Dilated-pupil acquisition. CFP. 50° FOV. Posterior pole view:
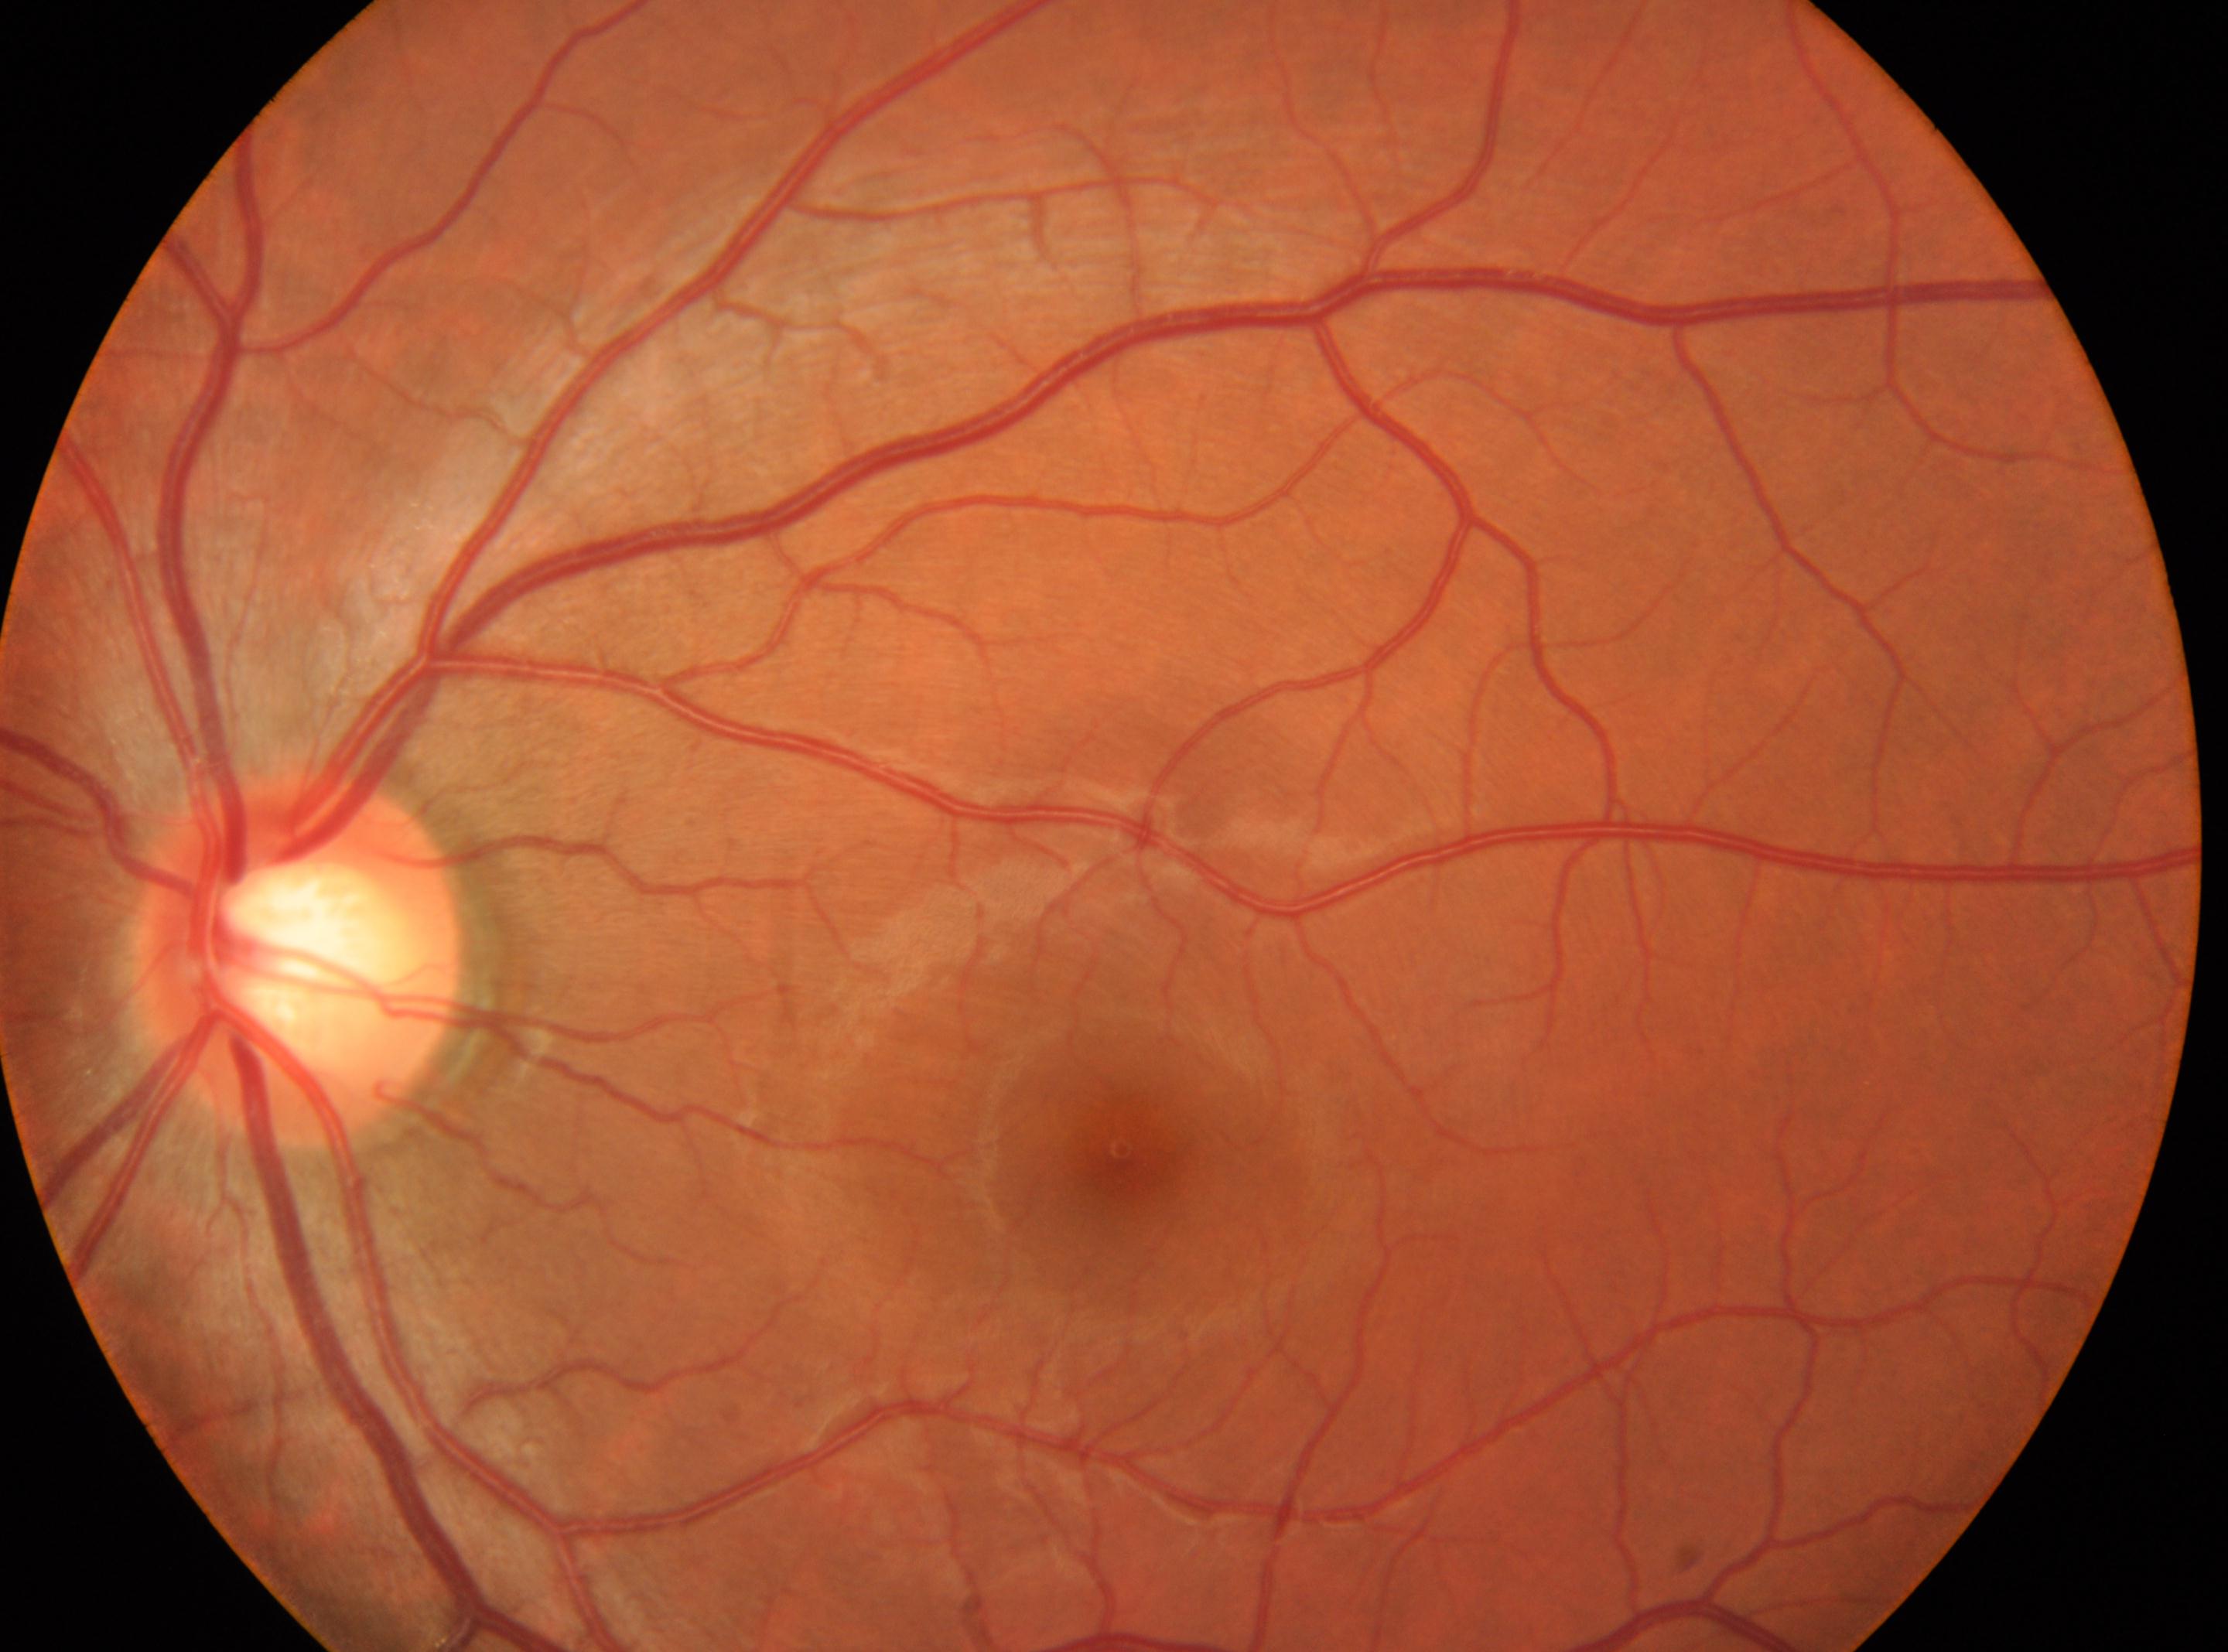

laterality = oculus sinister, fovea center = (1120, 1148), diabetic retinopathy severity = no apparent retinopathy (grade 0), disc center = (300, 956).